Retinal fundus photograph. 1504x1000
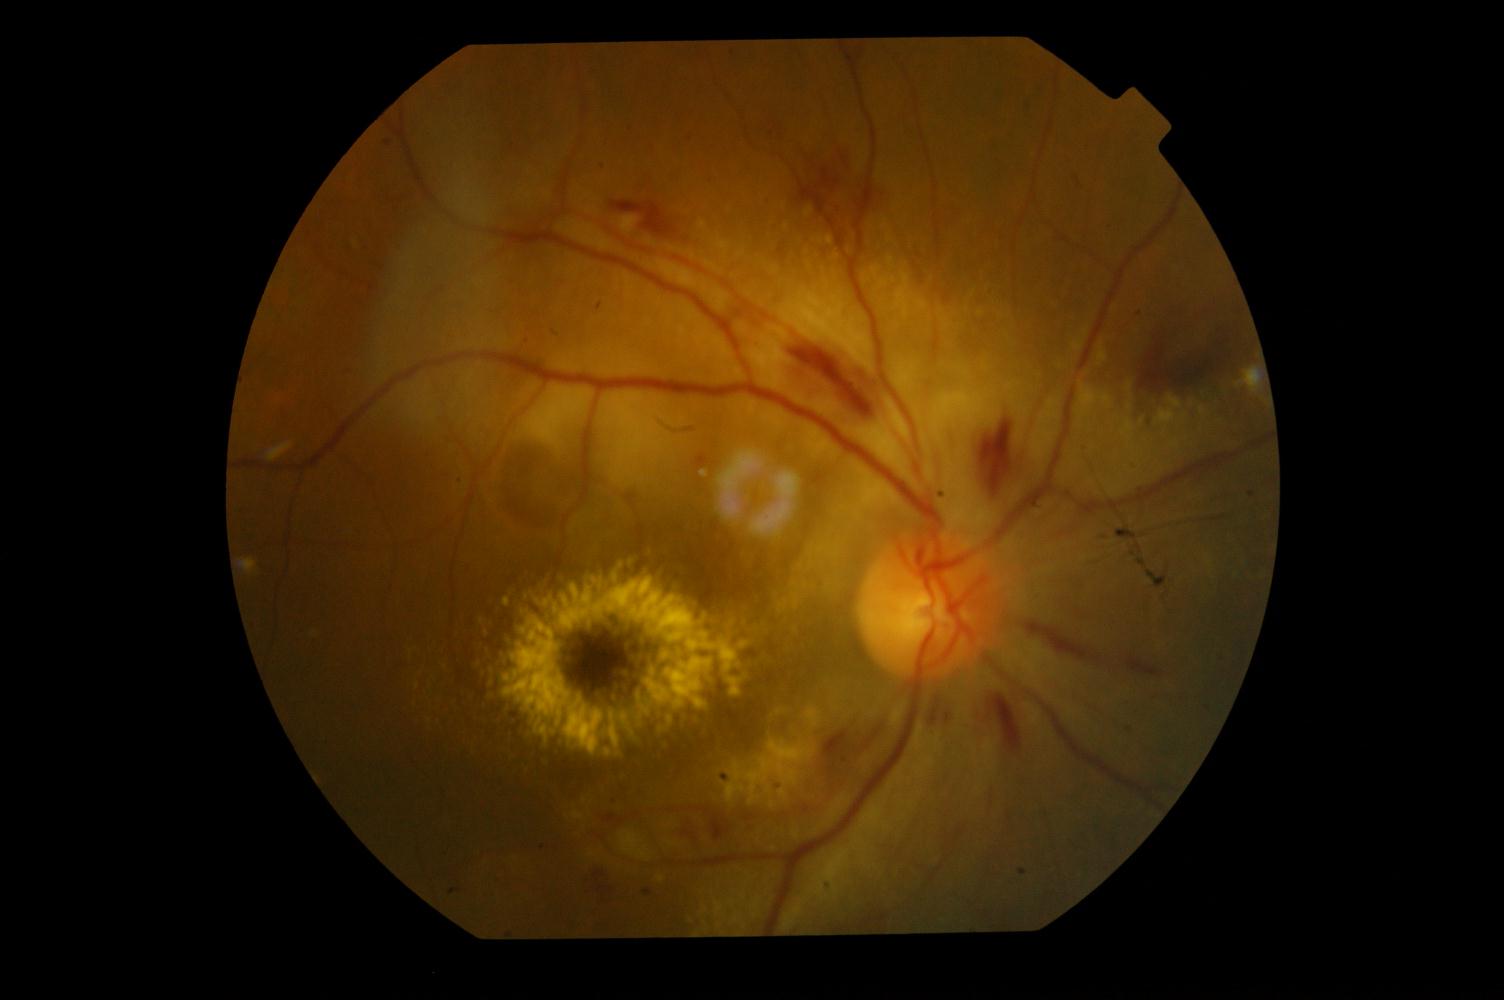
There is evidence of hypertensive retinopathy.